DR severity per modified Davis staging.
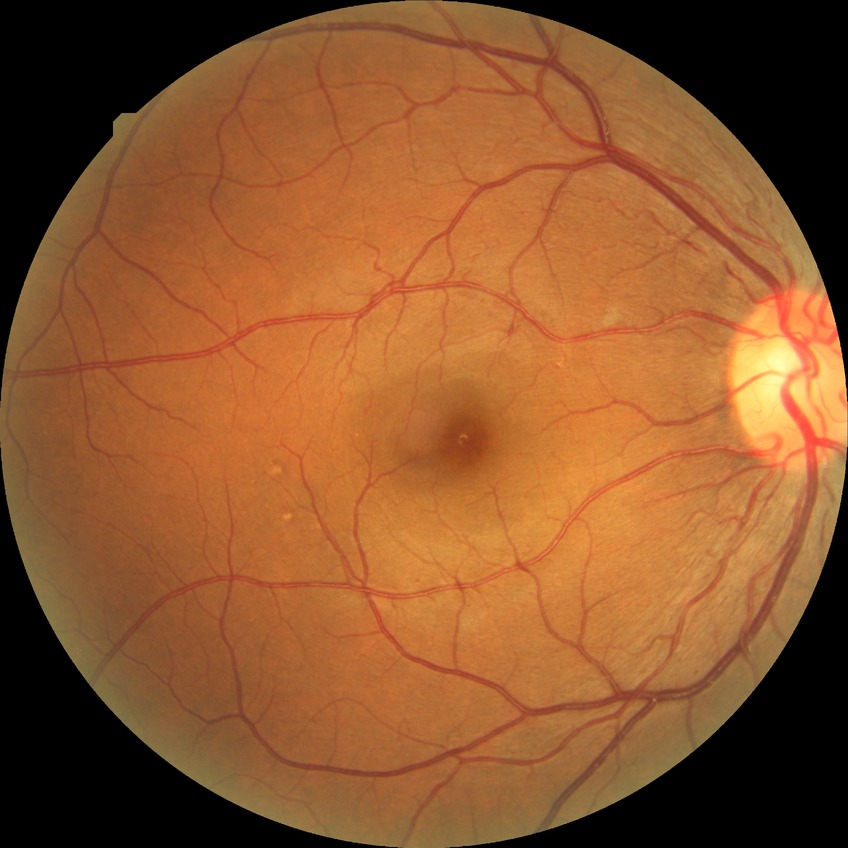 Disease class: non-proliferative diabetic retinopathy. Modified Davis grading is simple diabetic retinopathy.